Camera: Phoenix ICON (100° FOV) · wide-field fundus photograph from neonatal ROP screening — 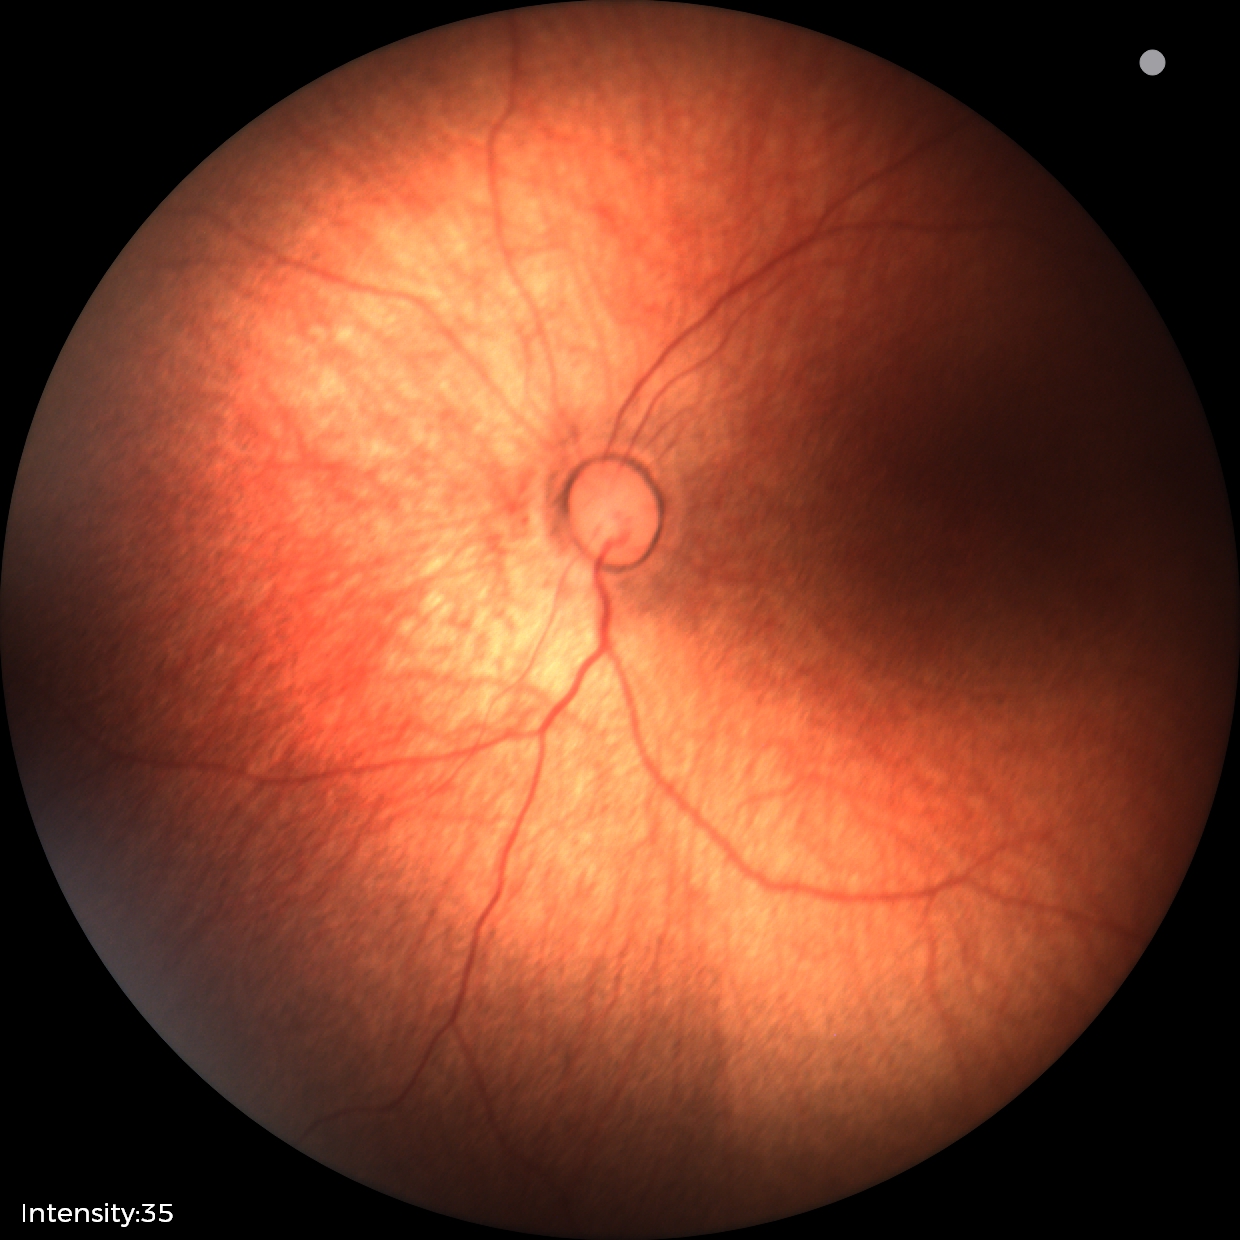
Diagnosis: normal.